45° FOV:
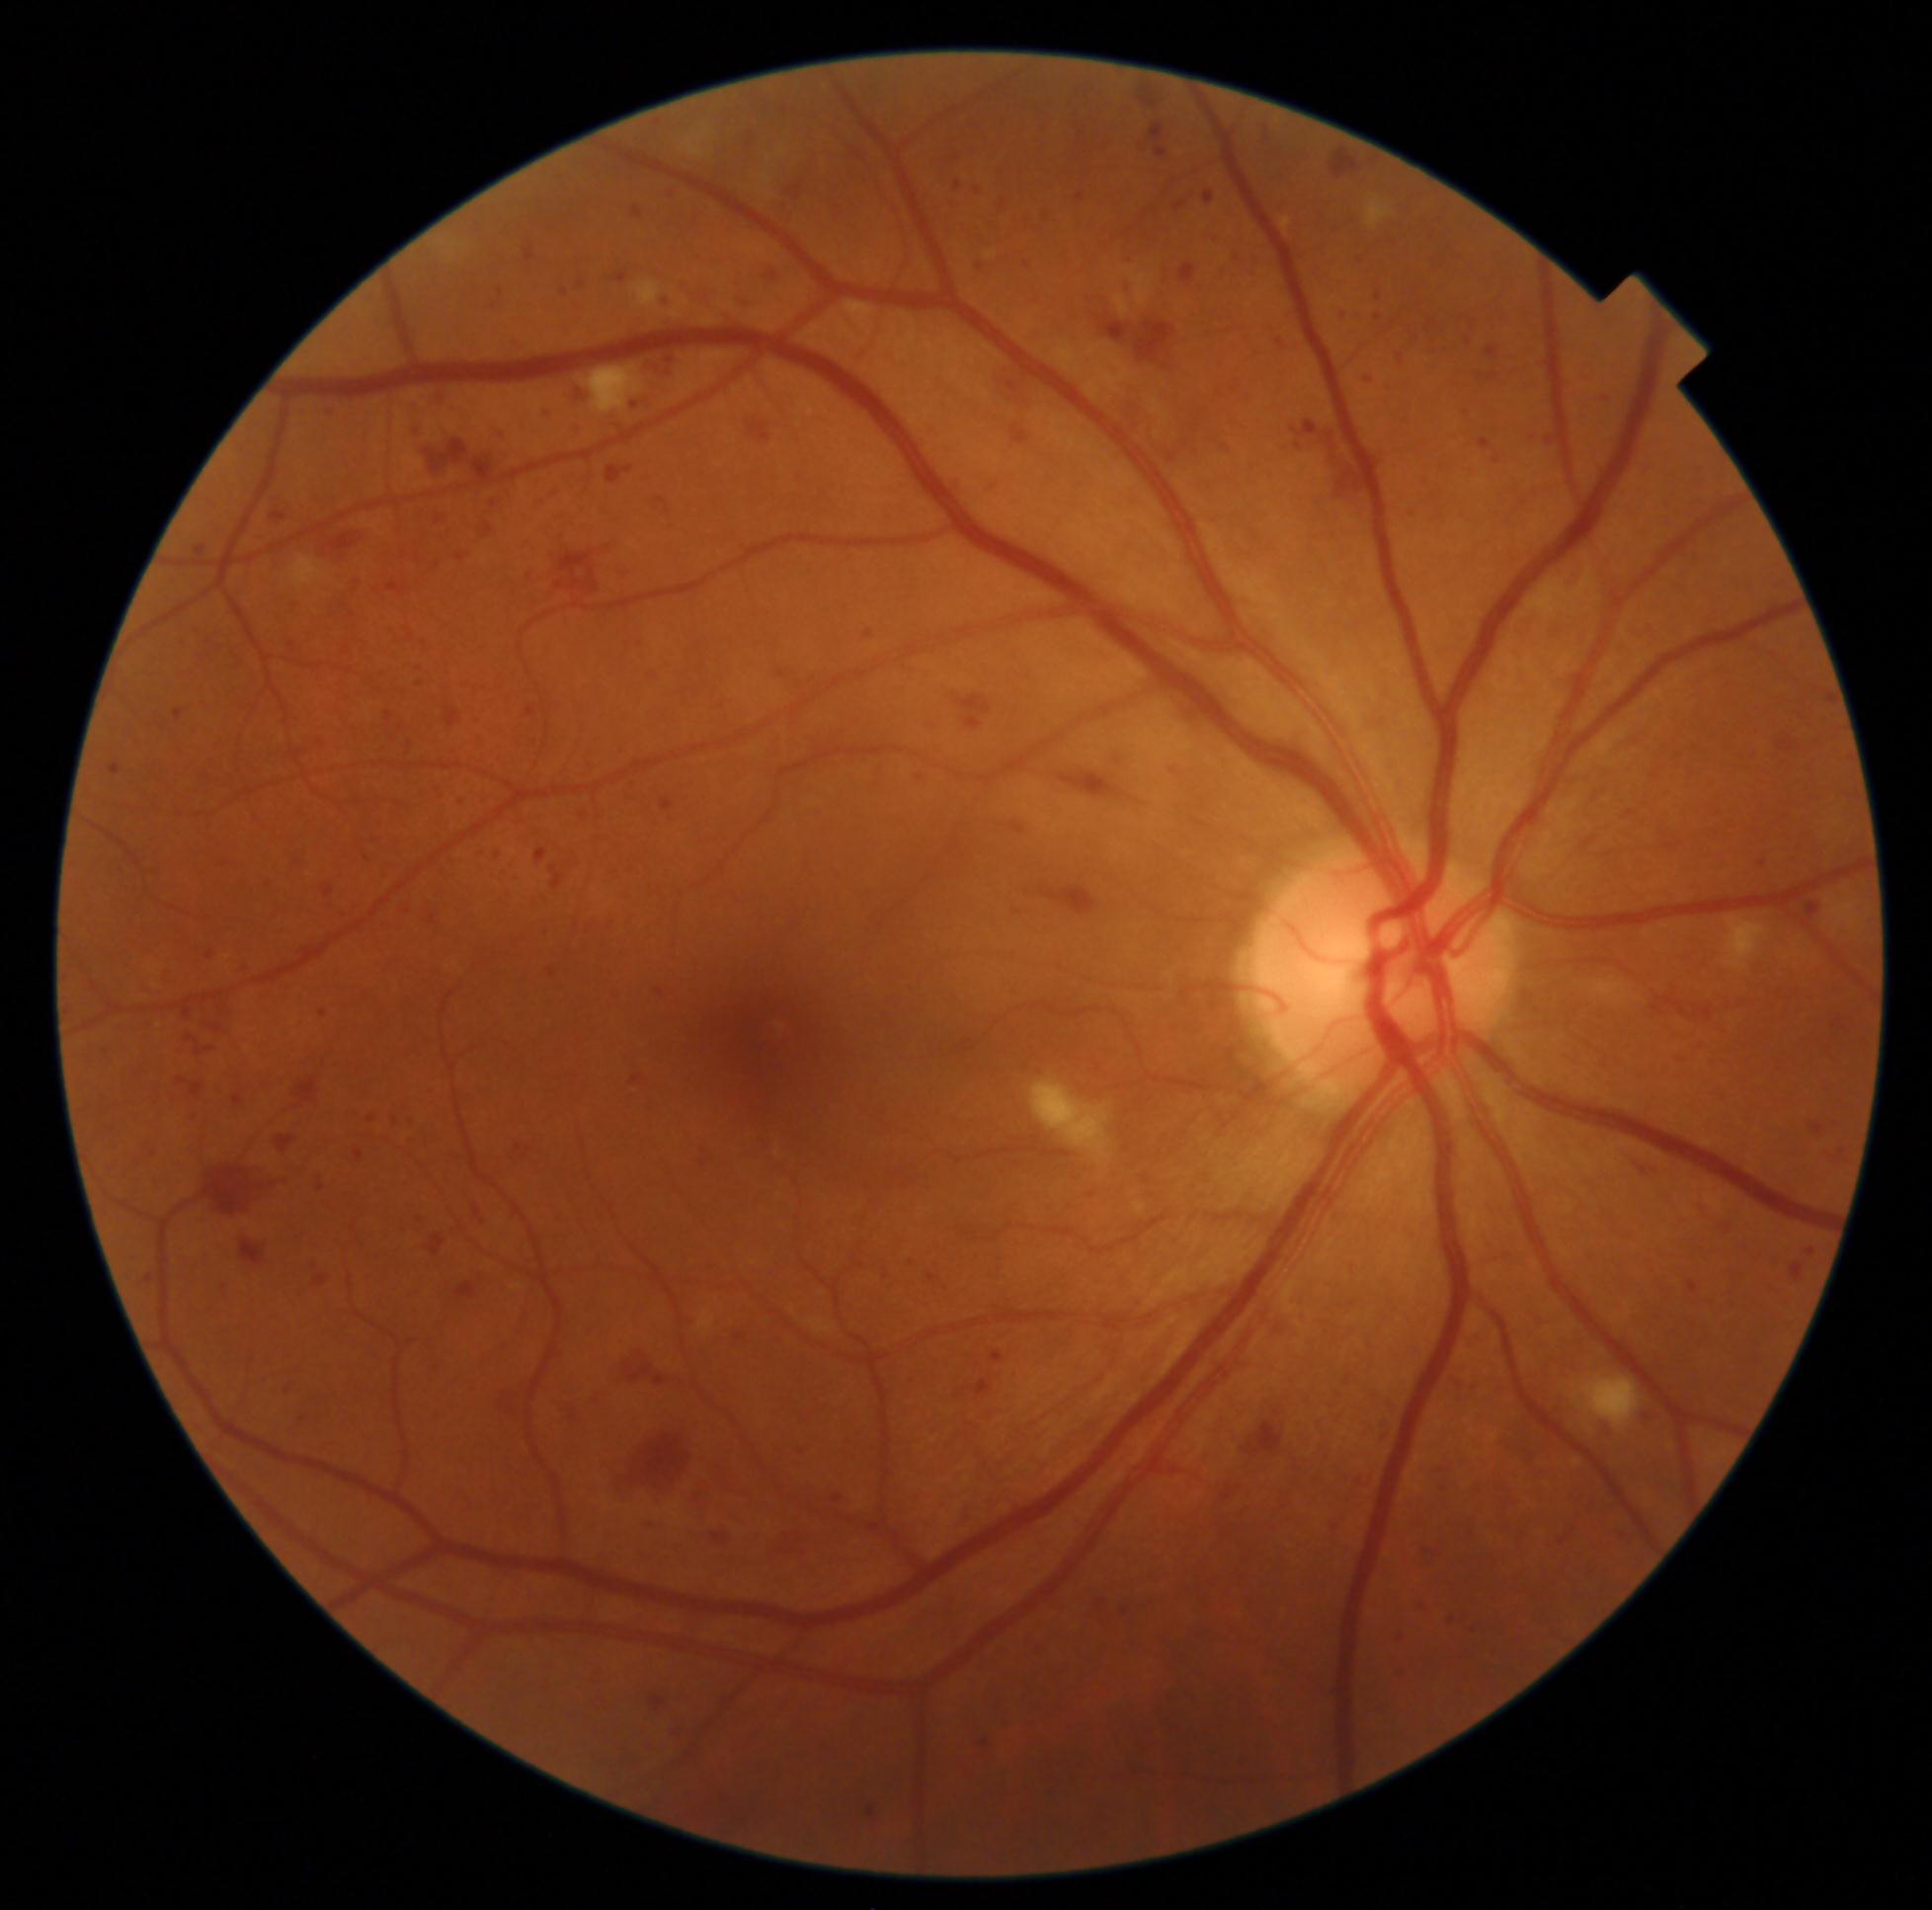

{"partial": true, "dr_grade": 3, "dr_grade_name": "severe NPDR", "lesions": {"he": [[1751, 1252, 1764, 1265], [446, 708, 461, 728], [238, 881, 252, 894], [1348, 1261, 1361, 1283], [650, 492, 679, 533], [1615, 285, 1638, 303], [693, 250, 705, 262], [632, 624, 647, 638], [378, 859, 400, 881], [1322, 1513, 1346, 1536], [159, 967, 177, 985], [1247, 268, 1259, 278], [1241, 1402, 1287, 1459], [973, 1379, 993, 1396], [1545, 615, 1574, 640], [1823, 1243, 1832, 1252], [1227, 379, 1243, 394]], "he_small_centers": [[1562, 1543], [658, 123]]}}